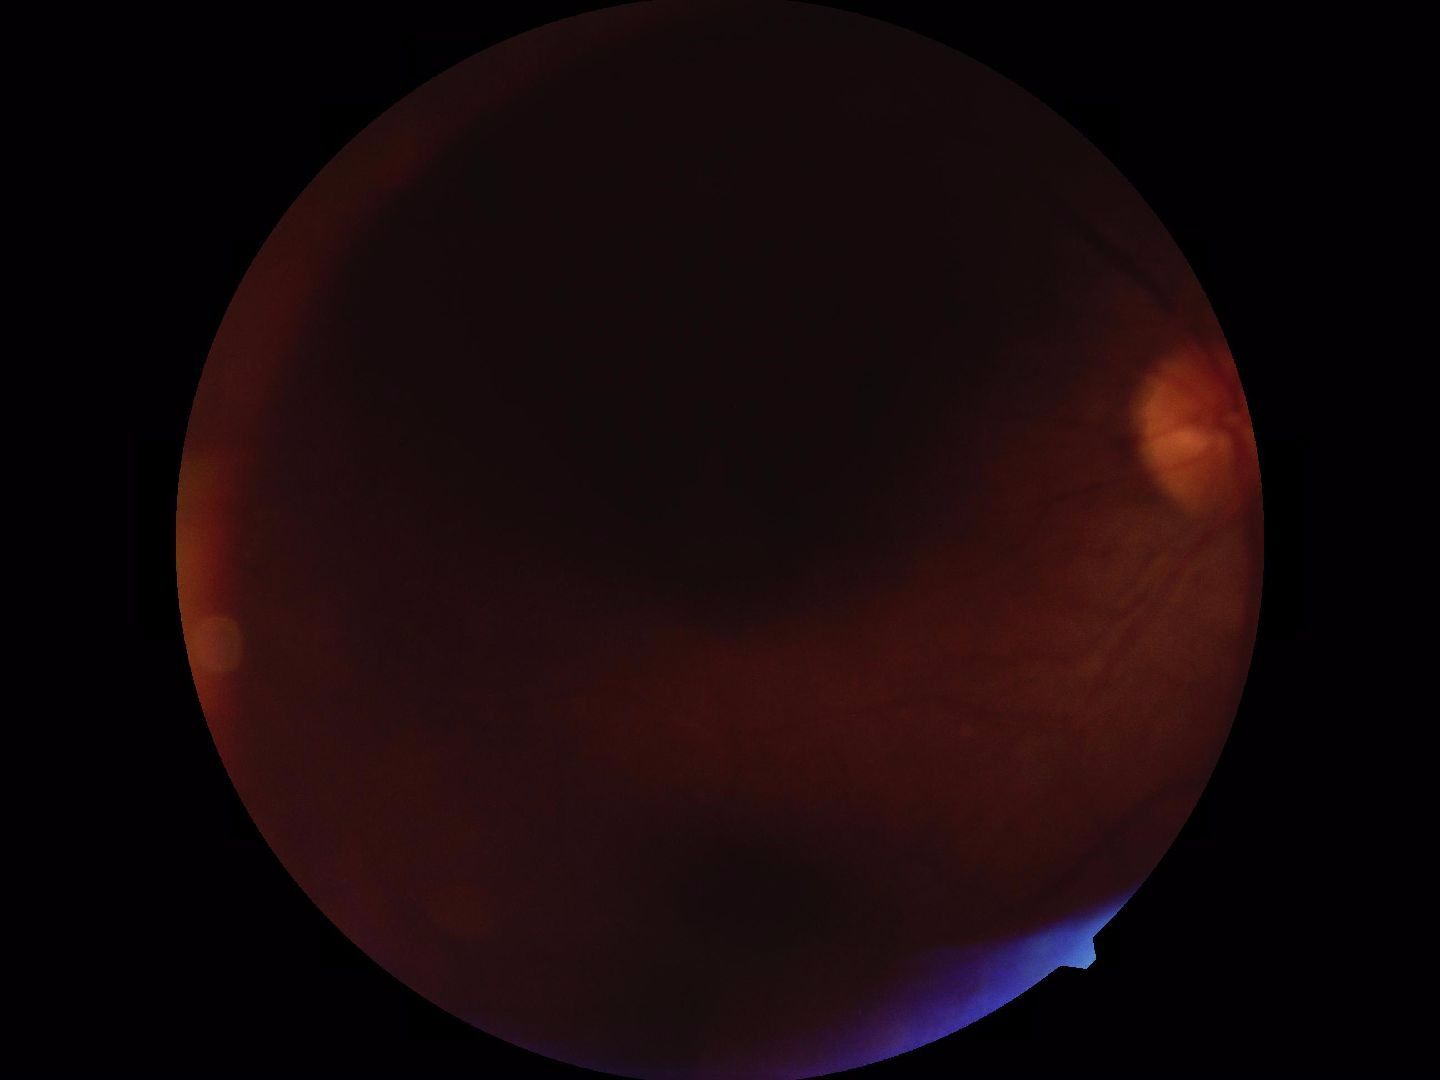
Blurred fundus image with substantial obscuration of retinal landmarks. Proliferative diabetic retinopathy not identified in the visible portion.